Color fundus photograph; 45-degree field of view; image size 1932x1932: 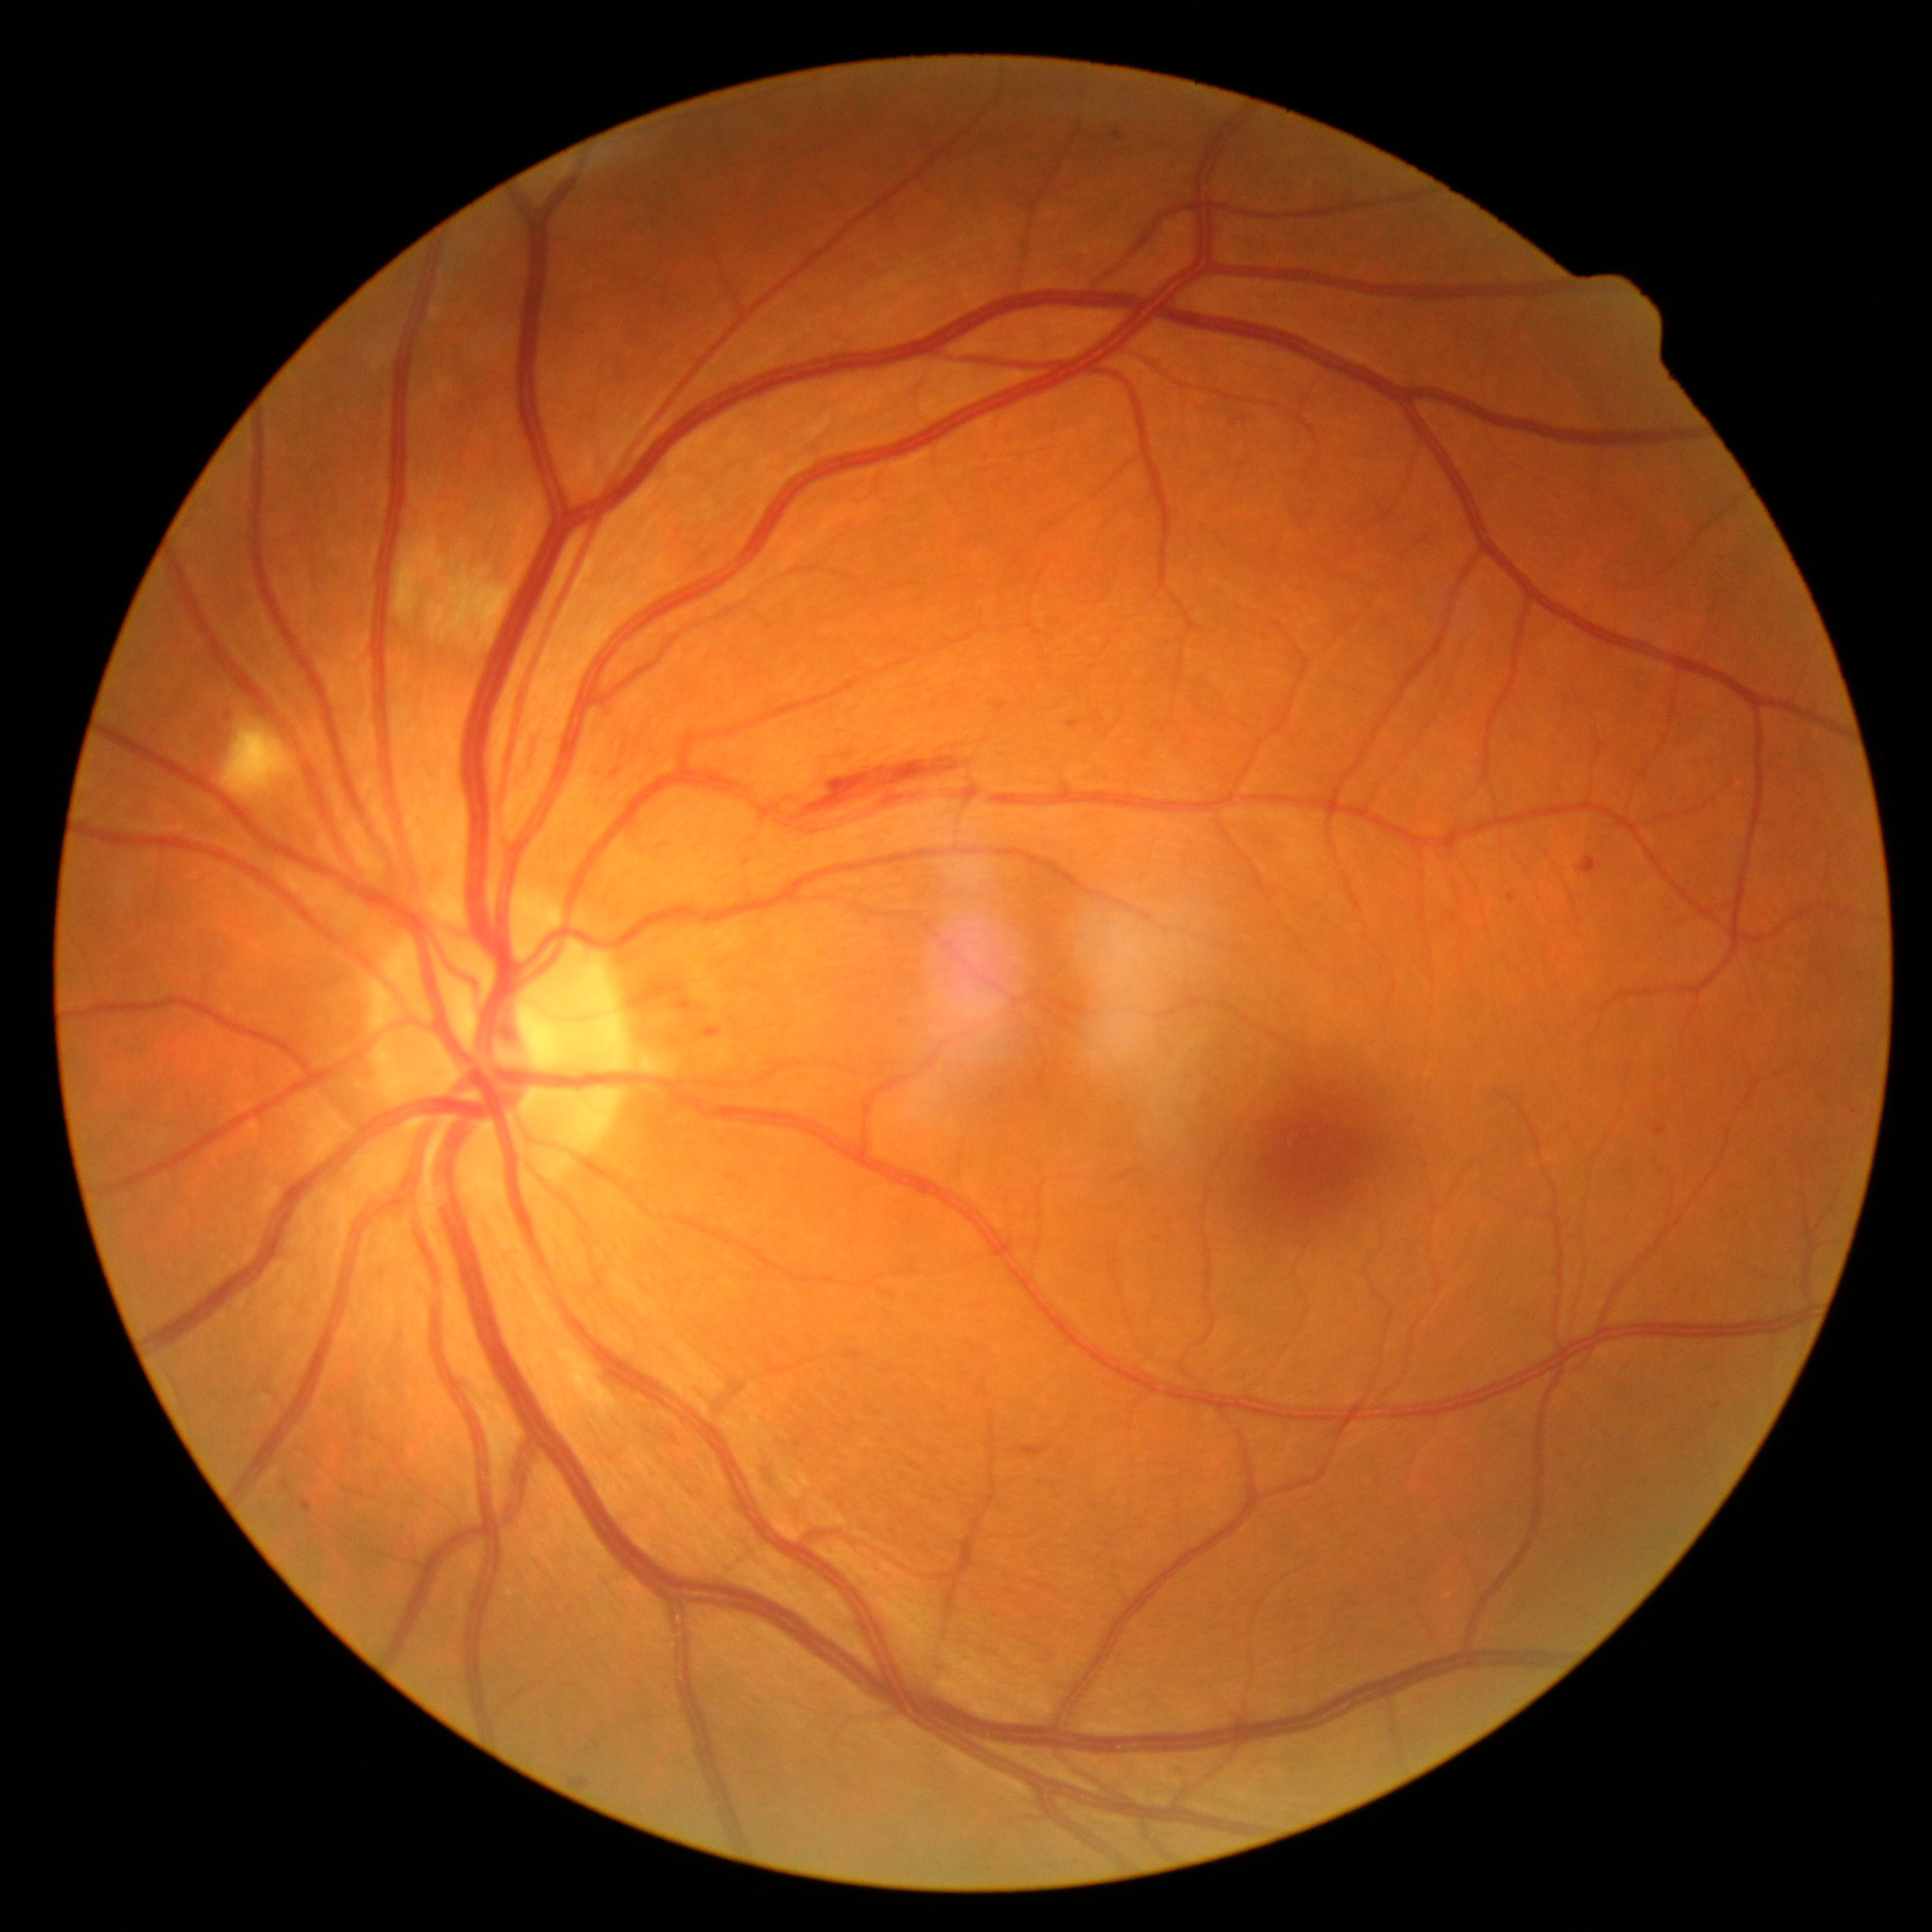 Diabetic retinopathy (DR): grade 2 (moderate NPDR)
hemorrhages (HEs) = {"left": 792, "top": 756, "right": 960, "bottom": 821} | {"left": 523, "top": 738, "right": 537, "bottom": 775}
soft exudates (SEs) = {"left": 221, "top": 717, "right": 298, "bottom": 802} | {"left": 395, "top": 537, "right": 447, "bottom": 620} | {"left": 428, "top": 566, "right": 512, "bottom": 642}
microaneurysms (MAs) = {"left": 593, "top": 766, "right": 602, "bottom": 773} | {"left": 703, "top": 1028, "right": 721, "bottom": 1037} | {"left": 1715, "top": 1400, "right": 1729, "bottom": 1409} | {"left": 1584, "top": 861, "right": 1596, "bottom": 867} | {"left": 1498, "top": 892, "right": 1511, "bottom": 903} | {"left": 1112, "top": 131, "right": 1125, "bottom": 139} | {"left": 1658, "top": 1123, "right": 1666, "bottom": 1138} | {"left": 1067, "top": 721, "right": 1079, "bottom": 730} | {"left": 570, "top": 1777, "right": 589, "bottom": 1791} | {"left": 301, "top": 1499, "right": 312, "bottom": 1512} | {"left": 1020, "top": 1445, "right": 1053, "bottom": 1456} | {"left": 676, "top": 998, "right": 694, "bottom": 1012}
MAs (small, approximate centers) near point(617, 772) | point(228, 716)
hard exudates (EXs) = none identified